Optic disc-centered crop from a color fundus photograph — 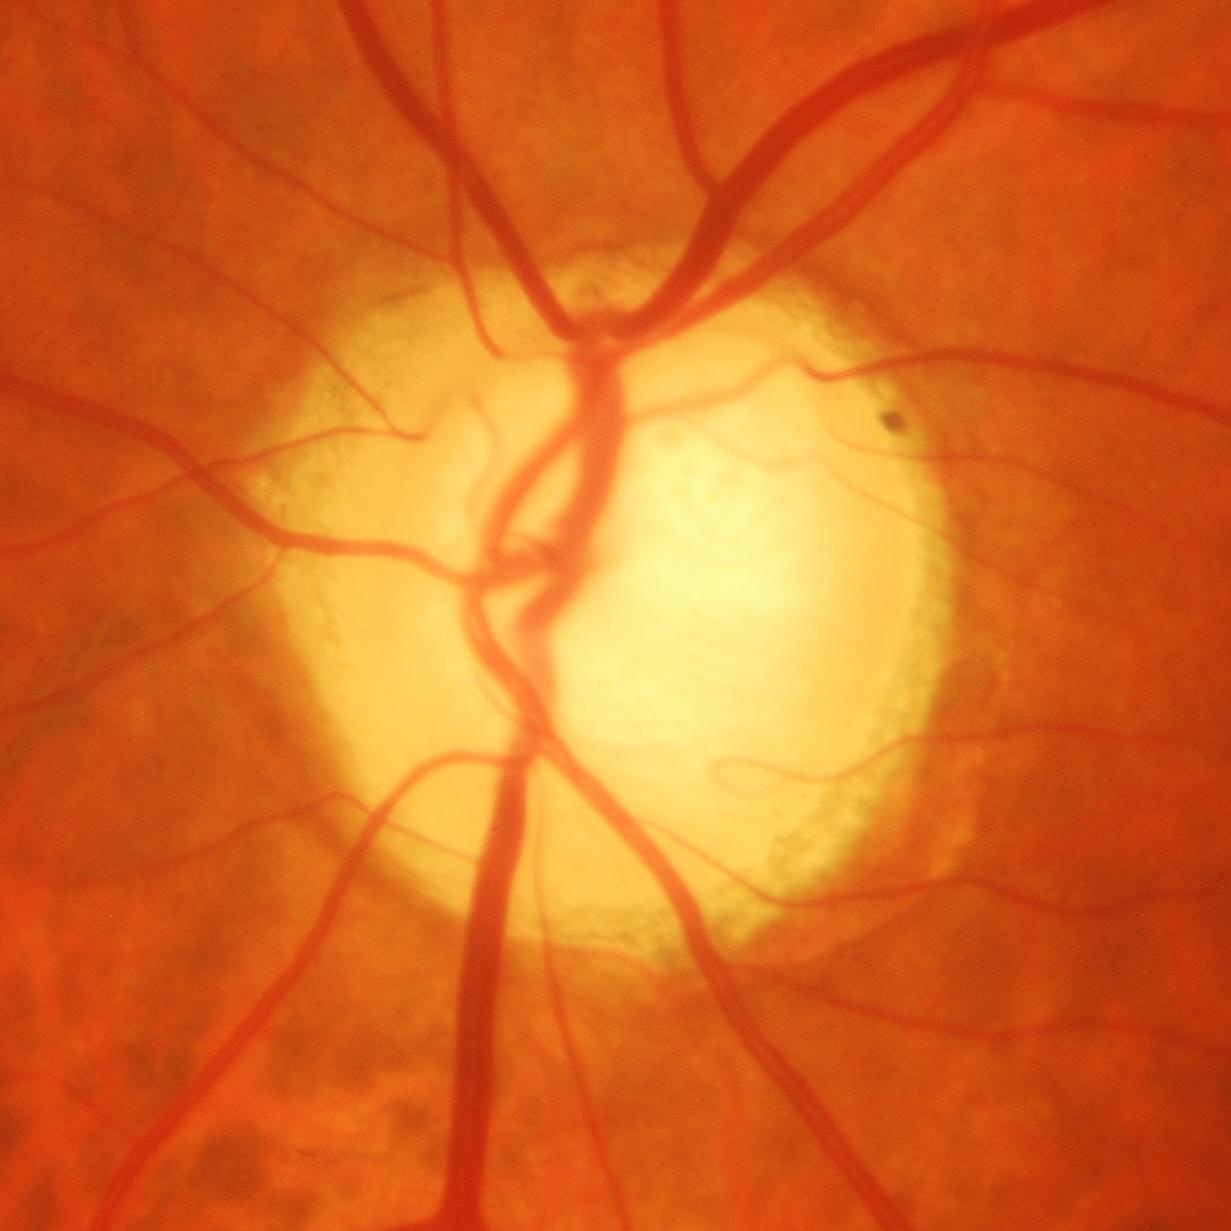
Glaucomatous optic neuropathy is present. Optic disc appearance consistent with glaucomatous damage to the optic nerve.